Acquired with a NIDEK AFC-230 · posterior pole color fundus photograph · 848 x 848 pixels · 45° FOV — 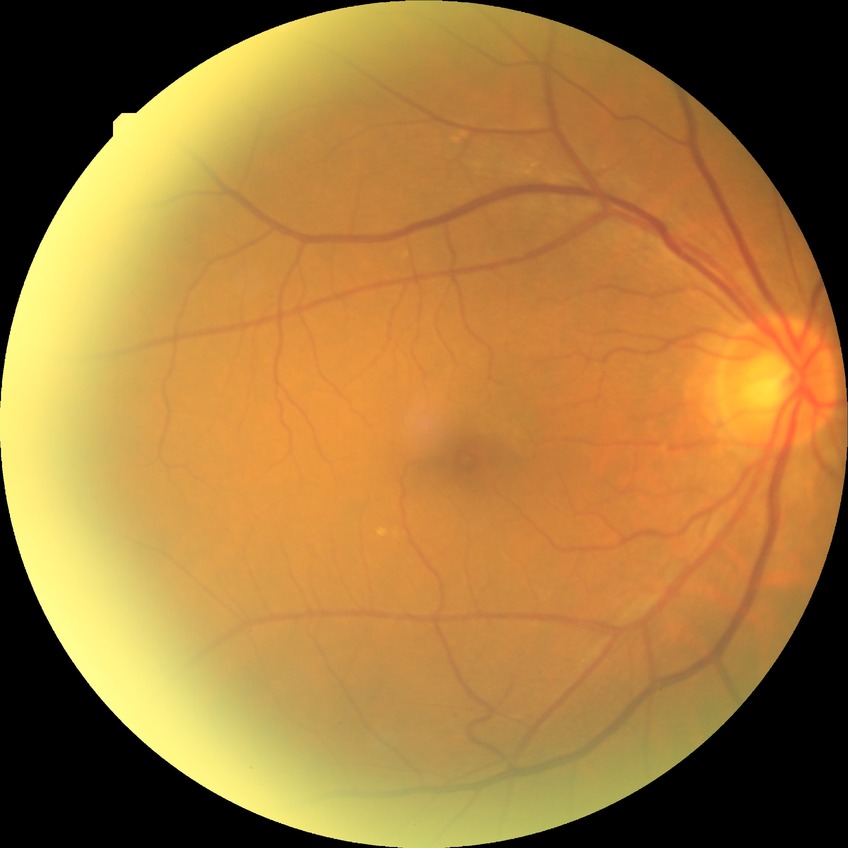

Diabetic retinopathy severity is no diabetic retinopathy.